CFP; 2212x1659: 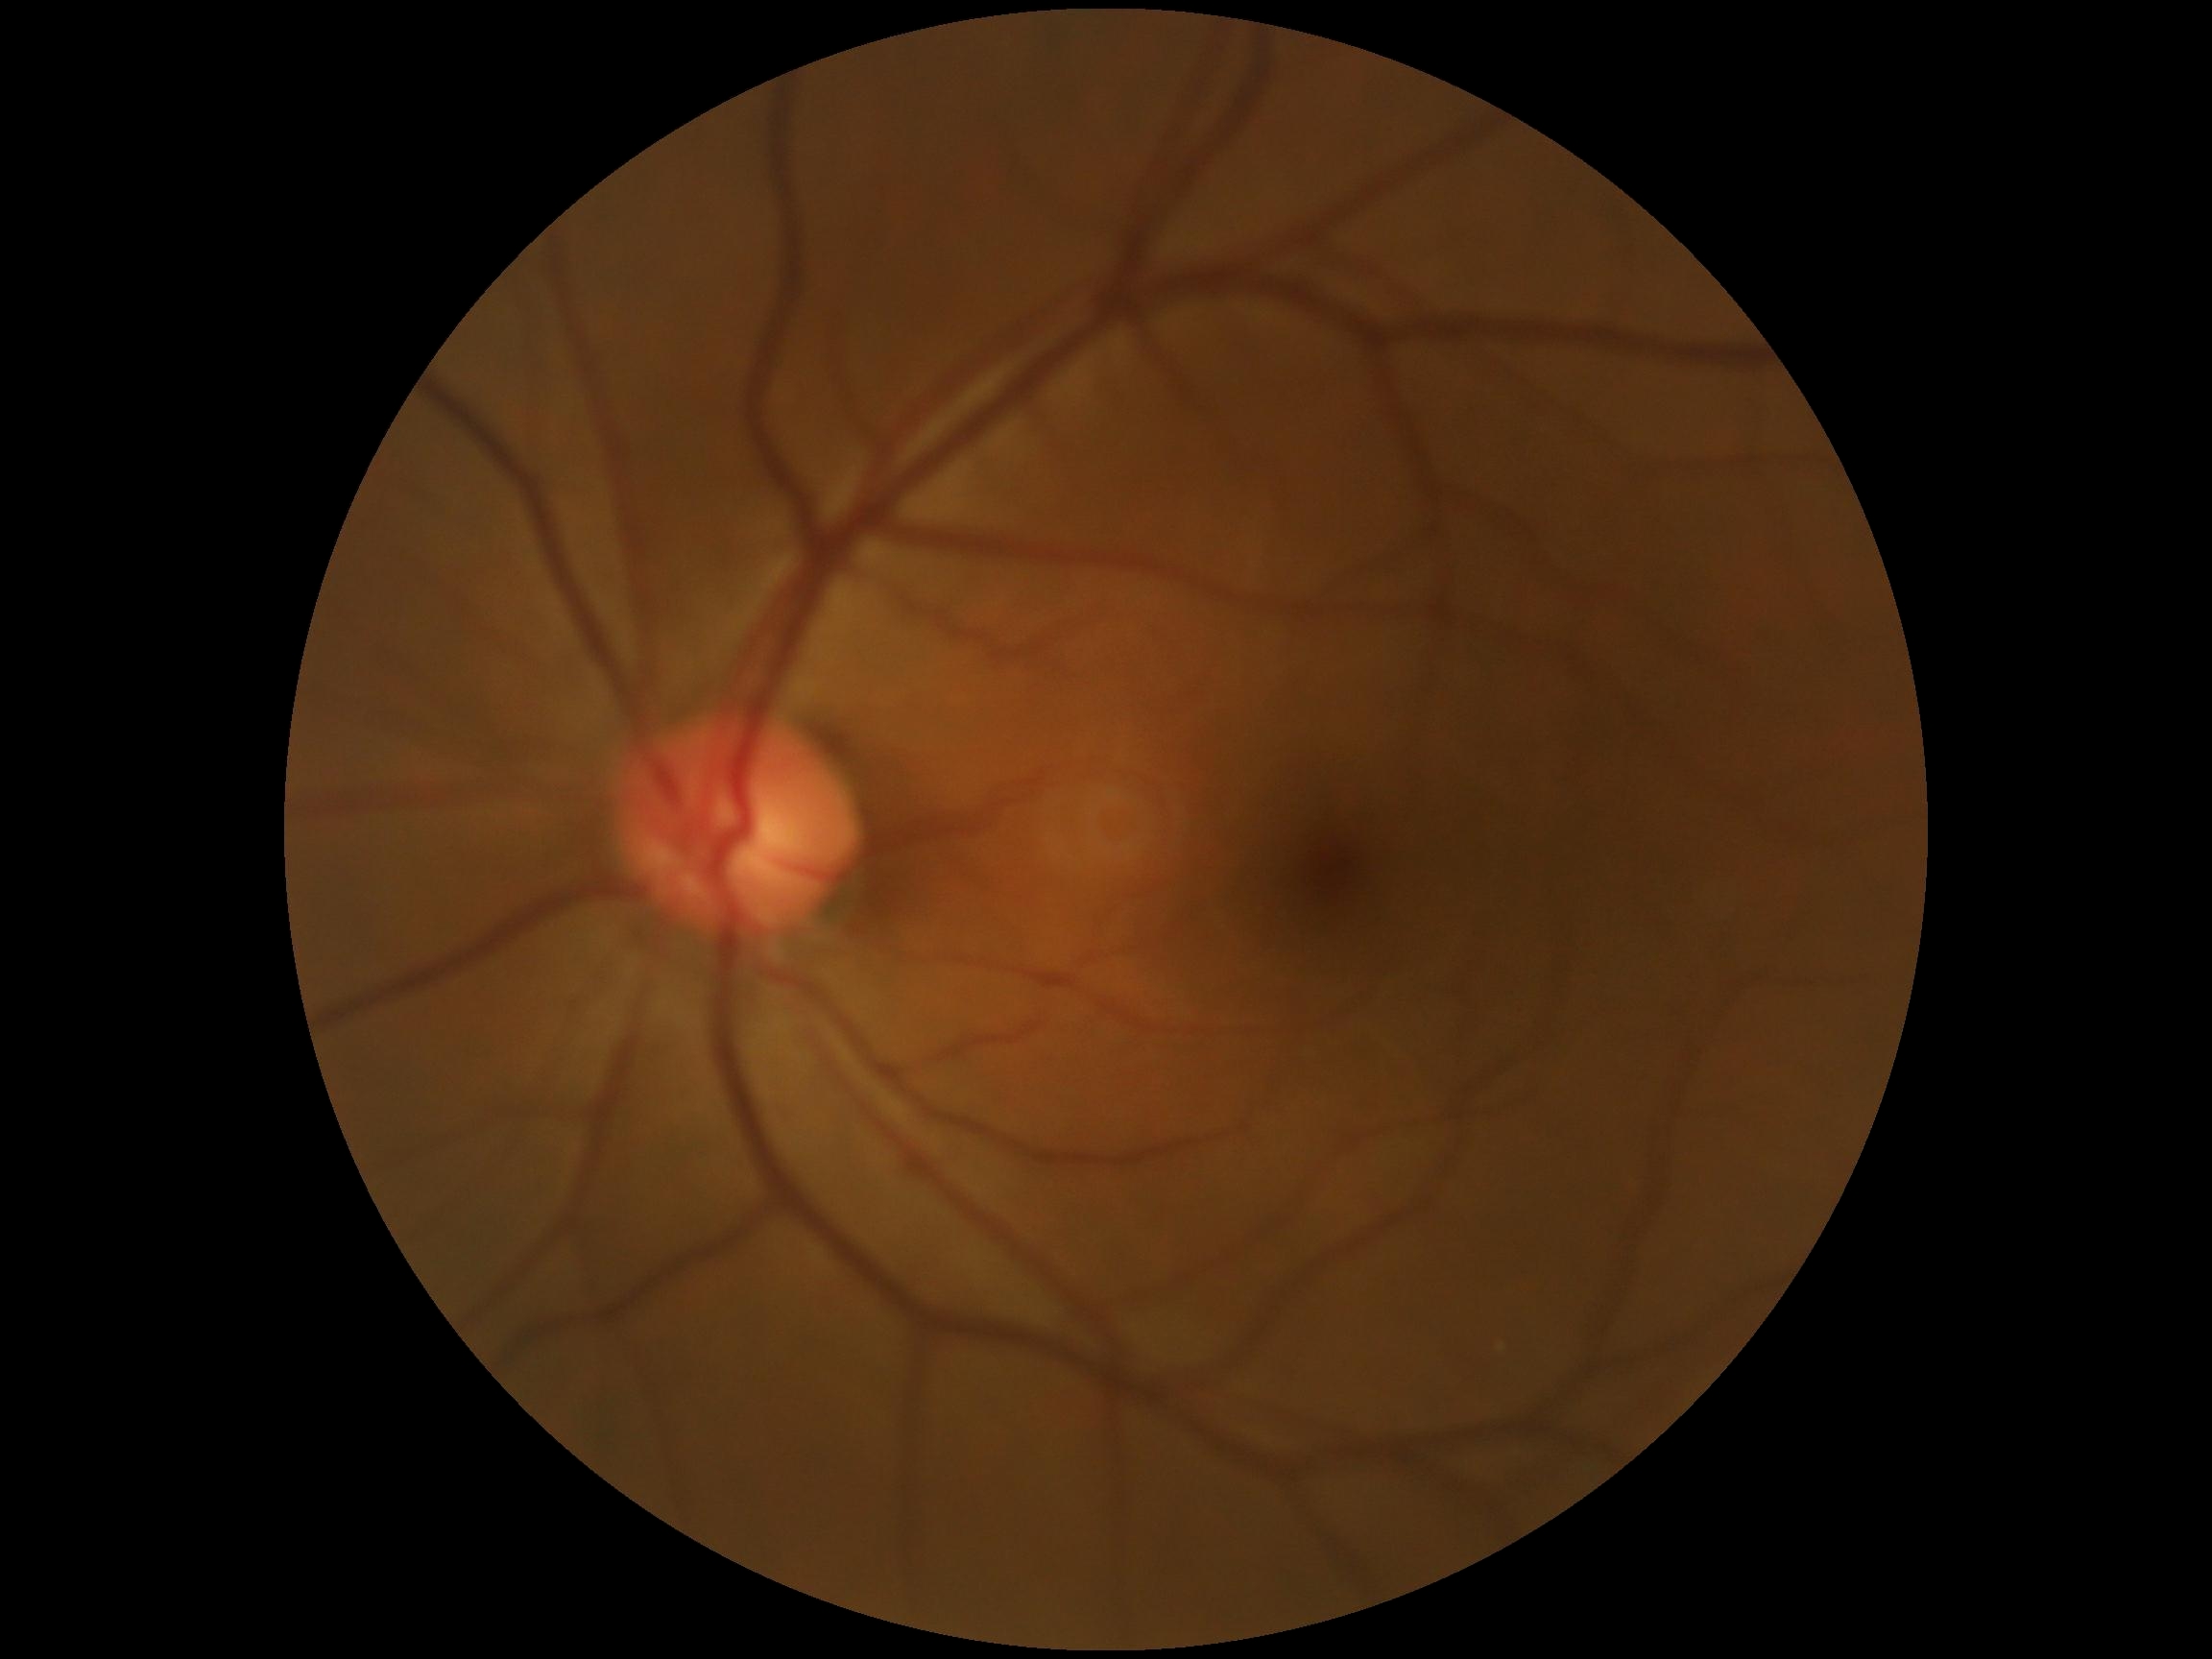
Diabetic retinopathy grade is 0 (no apparent retinopathy).